Davis DR grading.
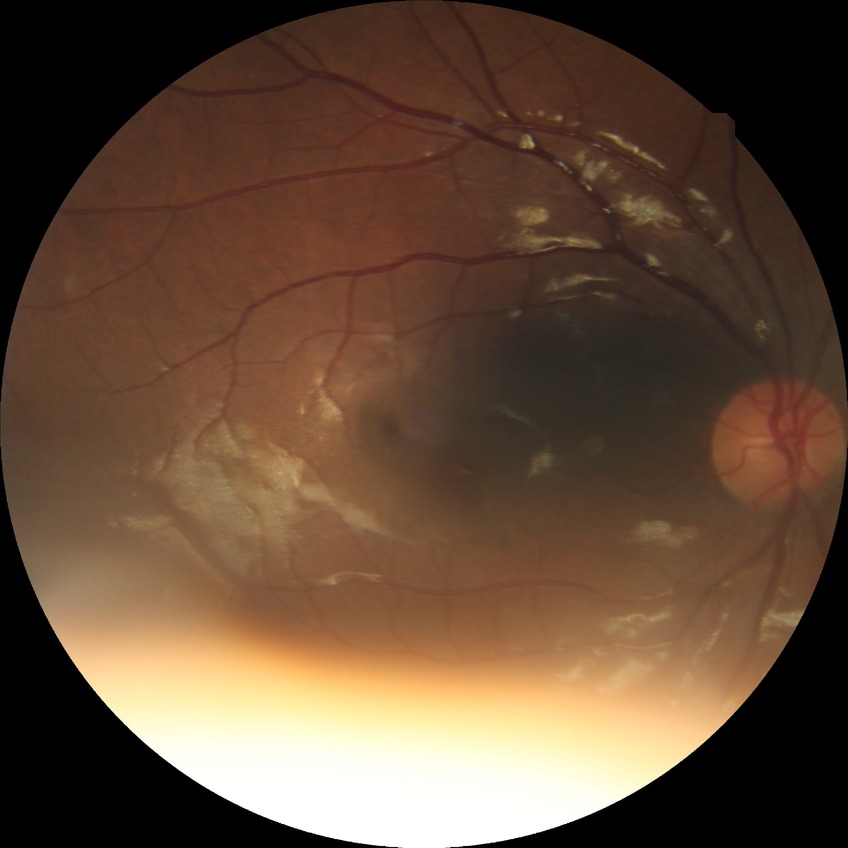 diabetic retinopathy severity=no diabetic retinopathy.